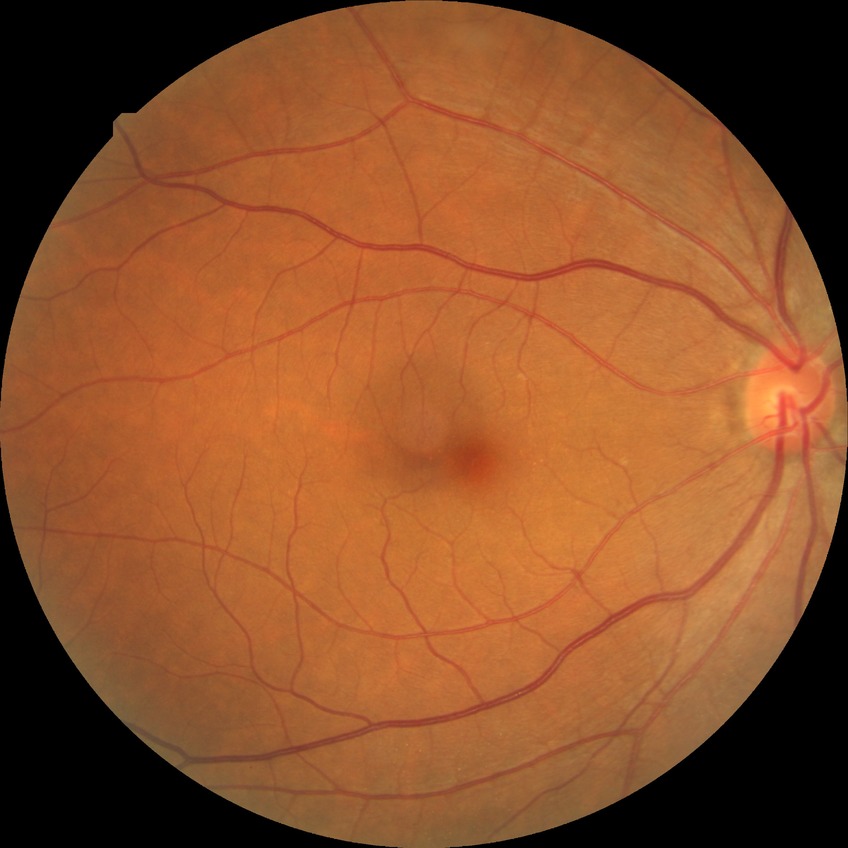 Diabetic retinopathy (DR) is no diabetic retinopathy (NDR).